Wide-field fundus photograph of an infant: 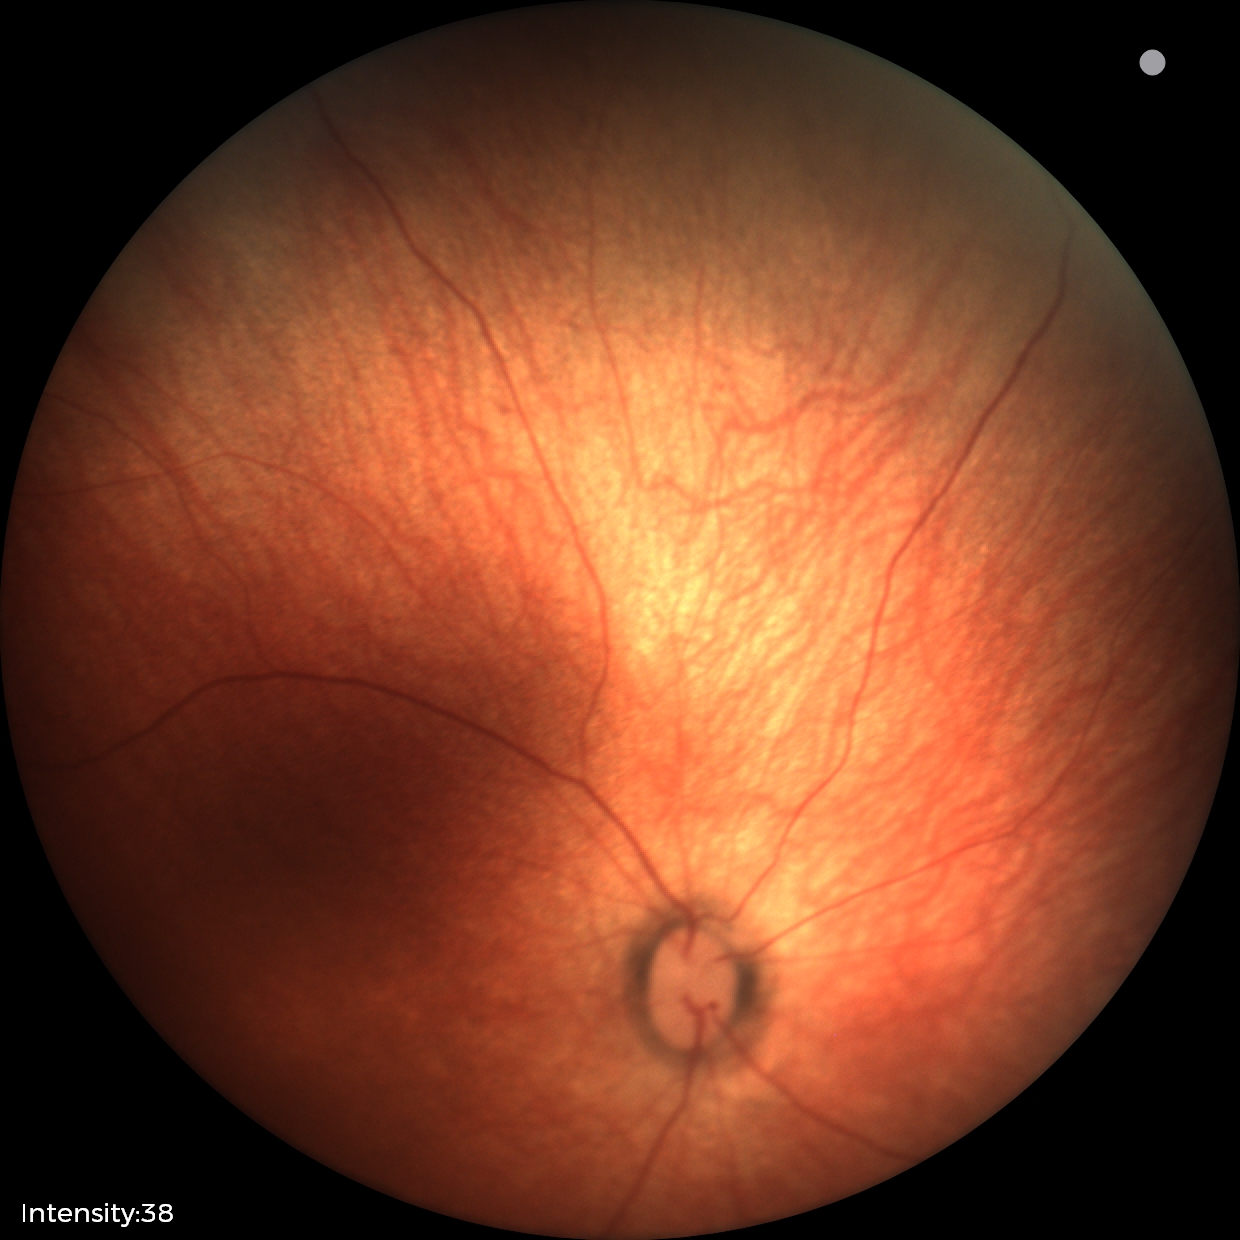
Physiological retinal appearance for postconceptual age.